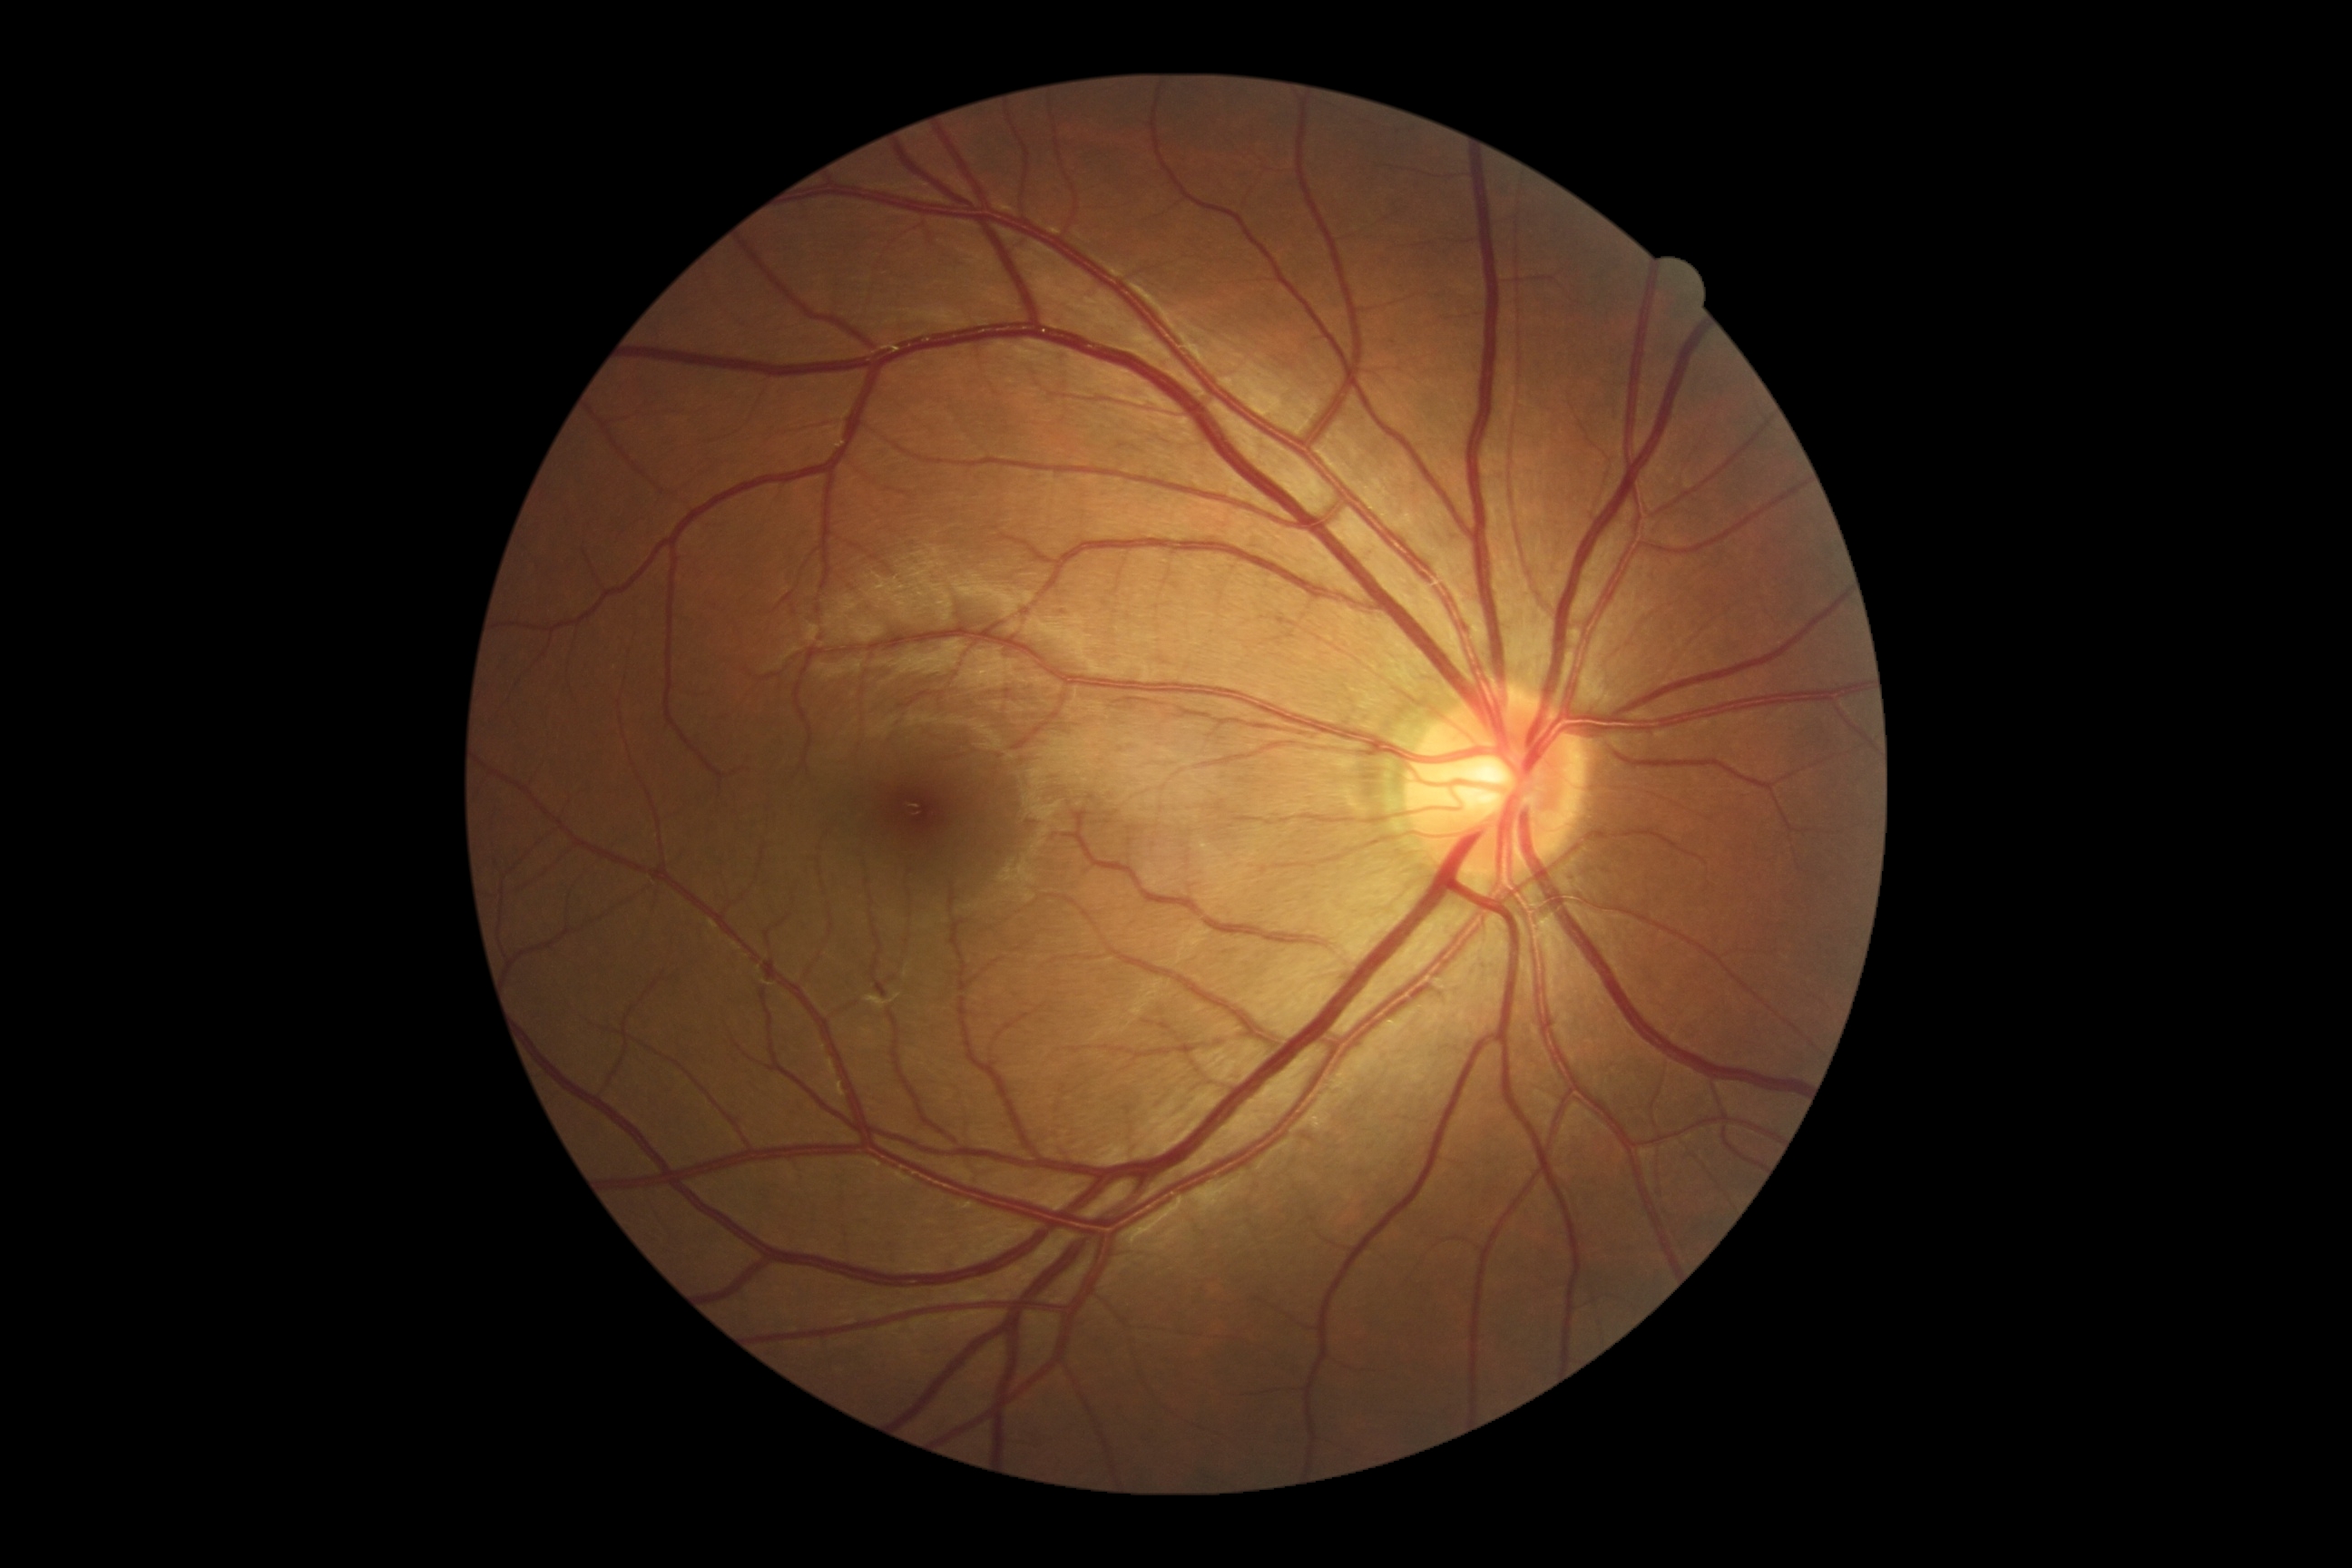

Diabetic retinopathy is no apparent diabetic retinopathy (grade 0).